Color fundus photograph · 2048x1536:
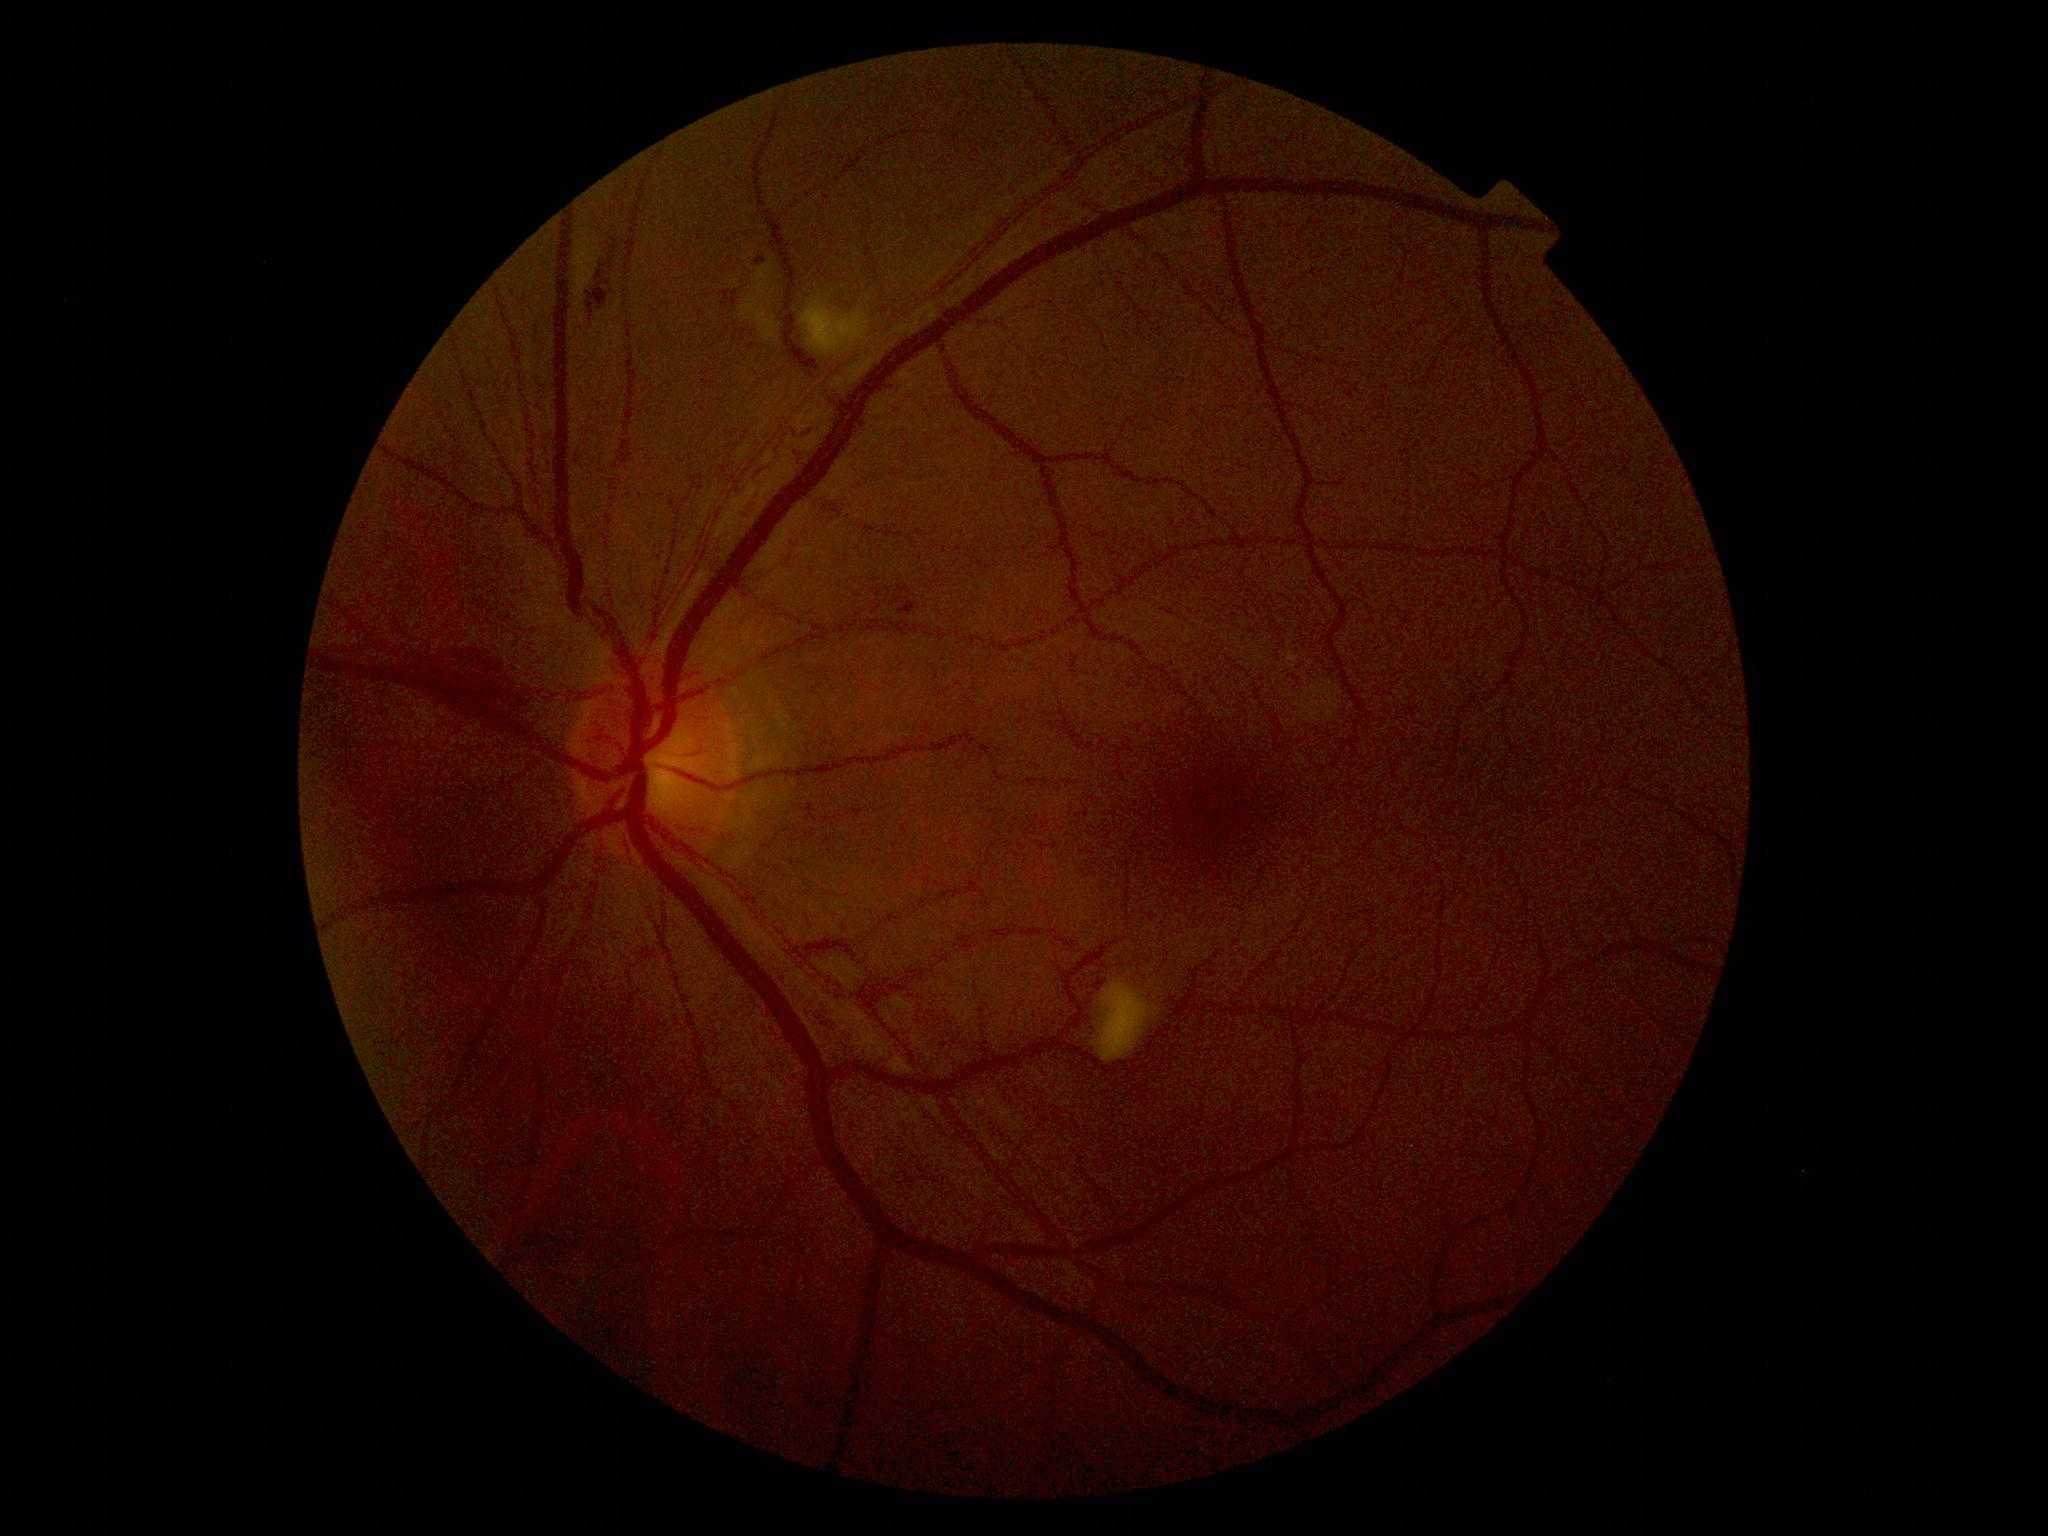
DR grade is 2 (moderate NPDR).